1659 x 2212 pixels.
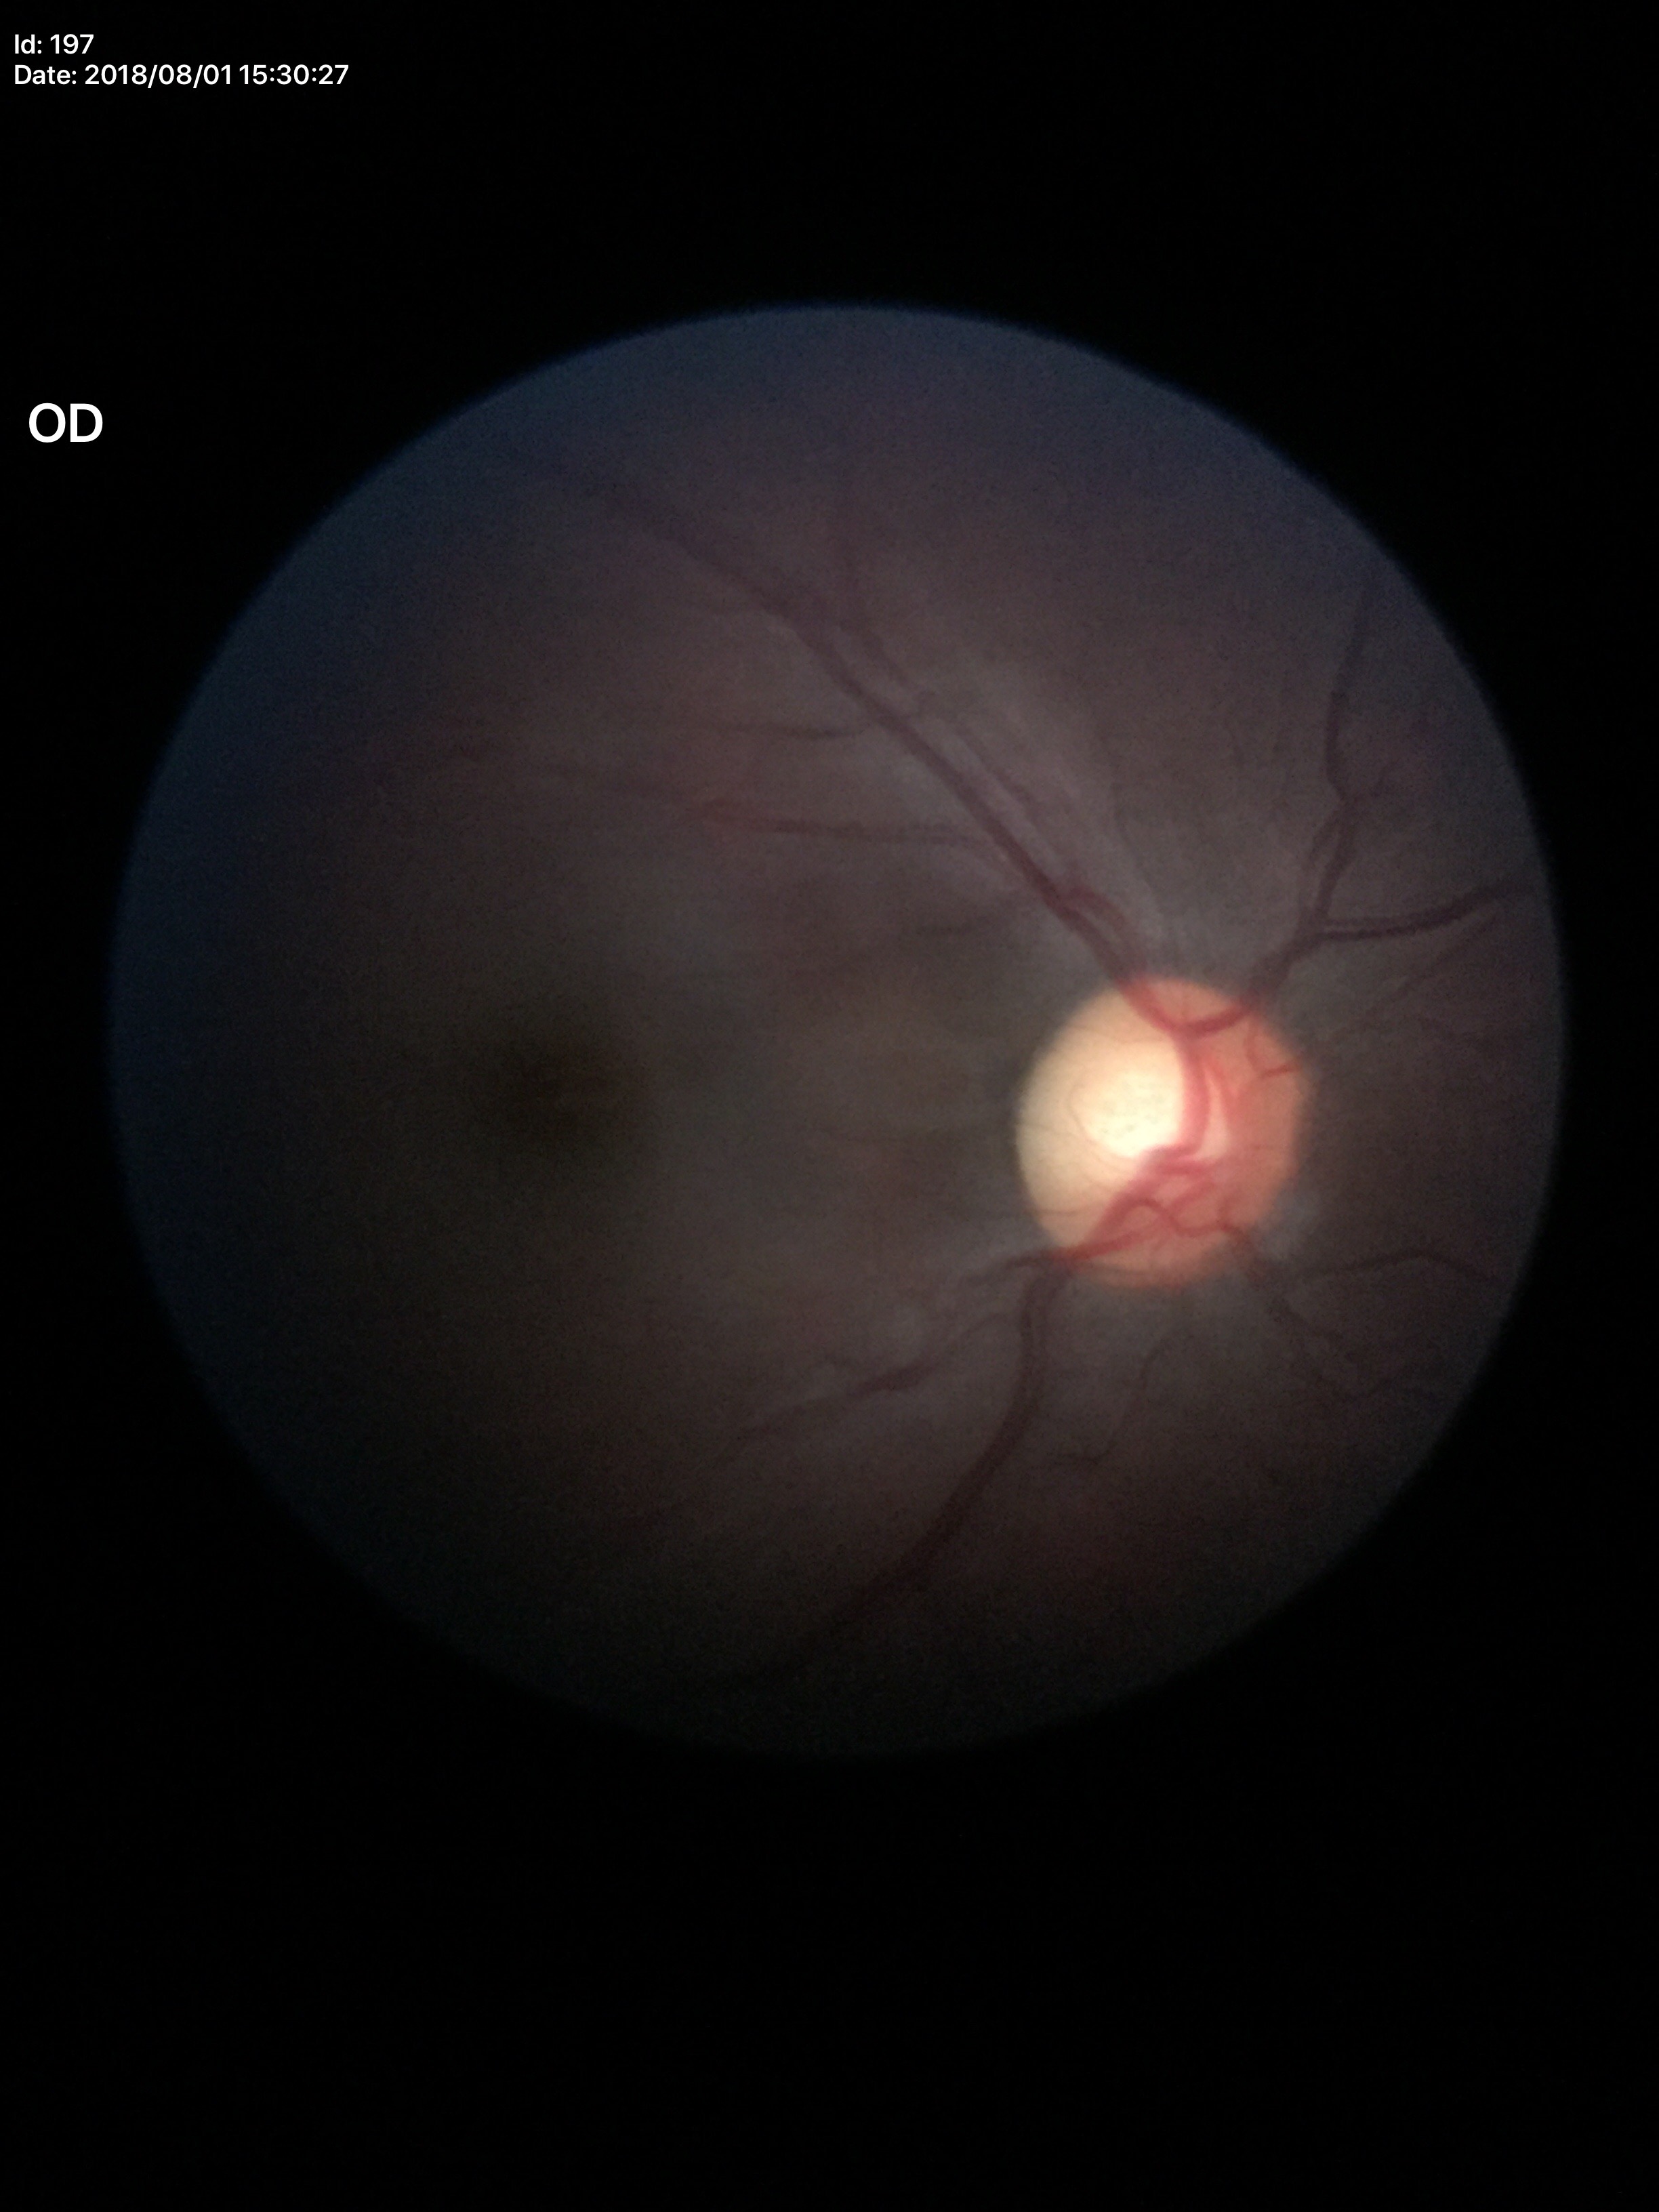
Glaucoma evaluation: negative (2 of 5 graders flagged glaucoma suspect)
vertical cup-disc ratio: 0.59
area cup-to-disc ratio: 0.37